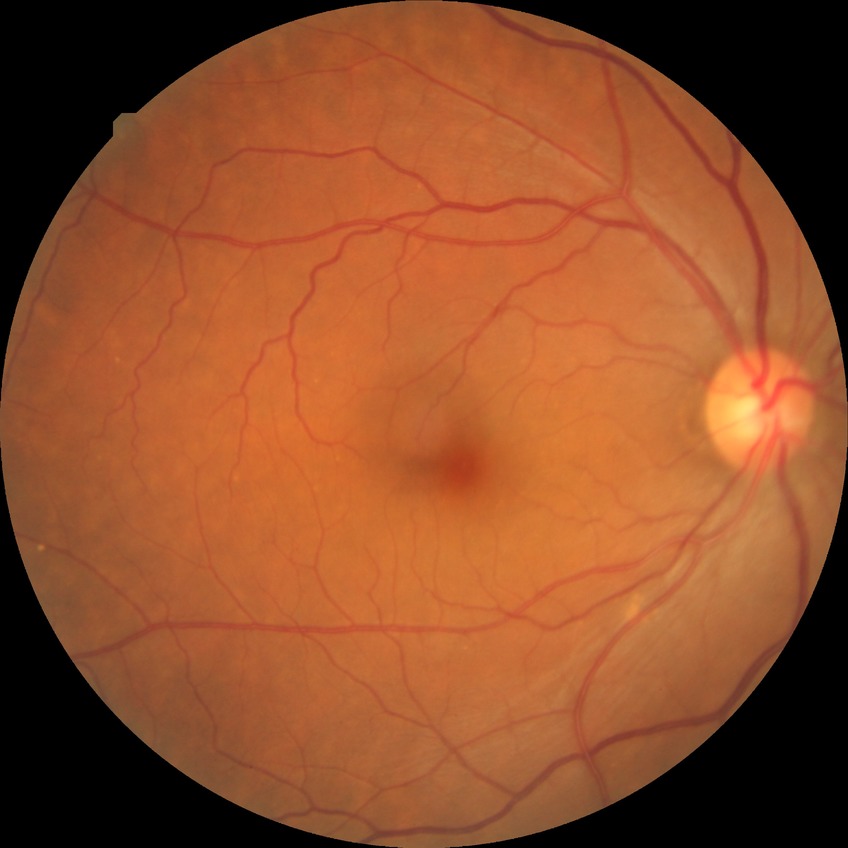 Retinopathy grade is no diabetic retinopathy.